50° field of view
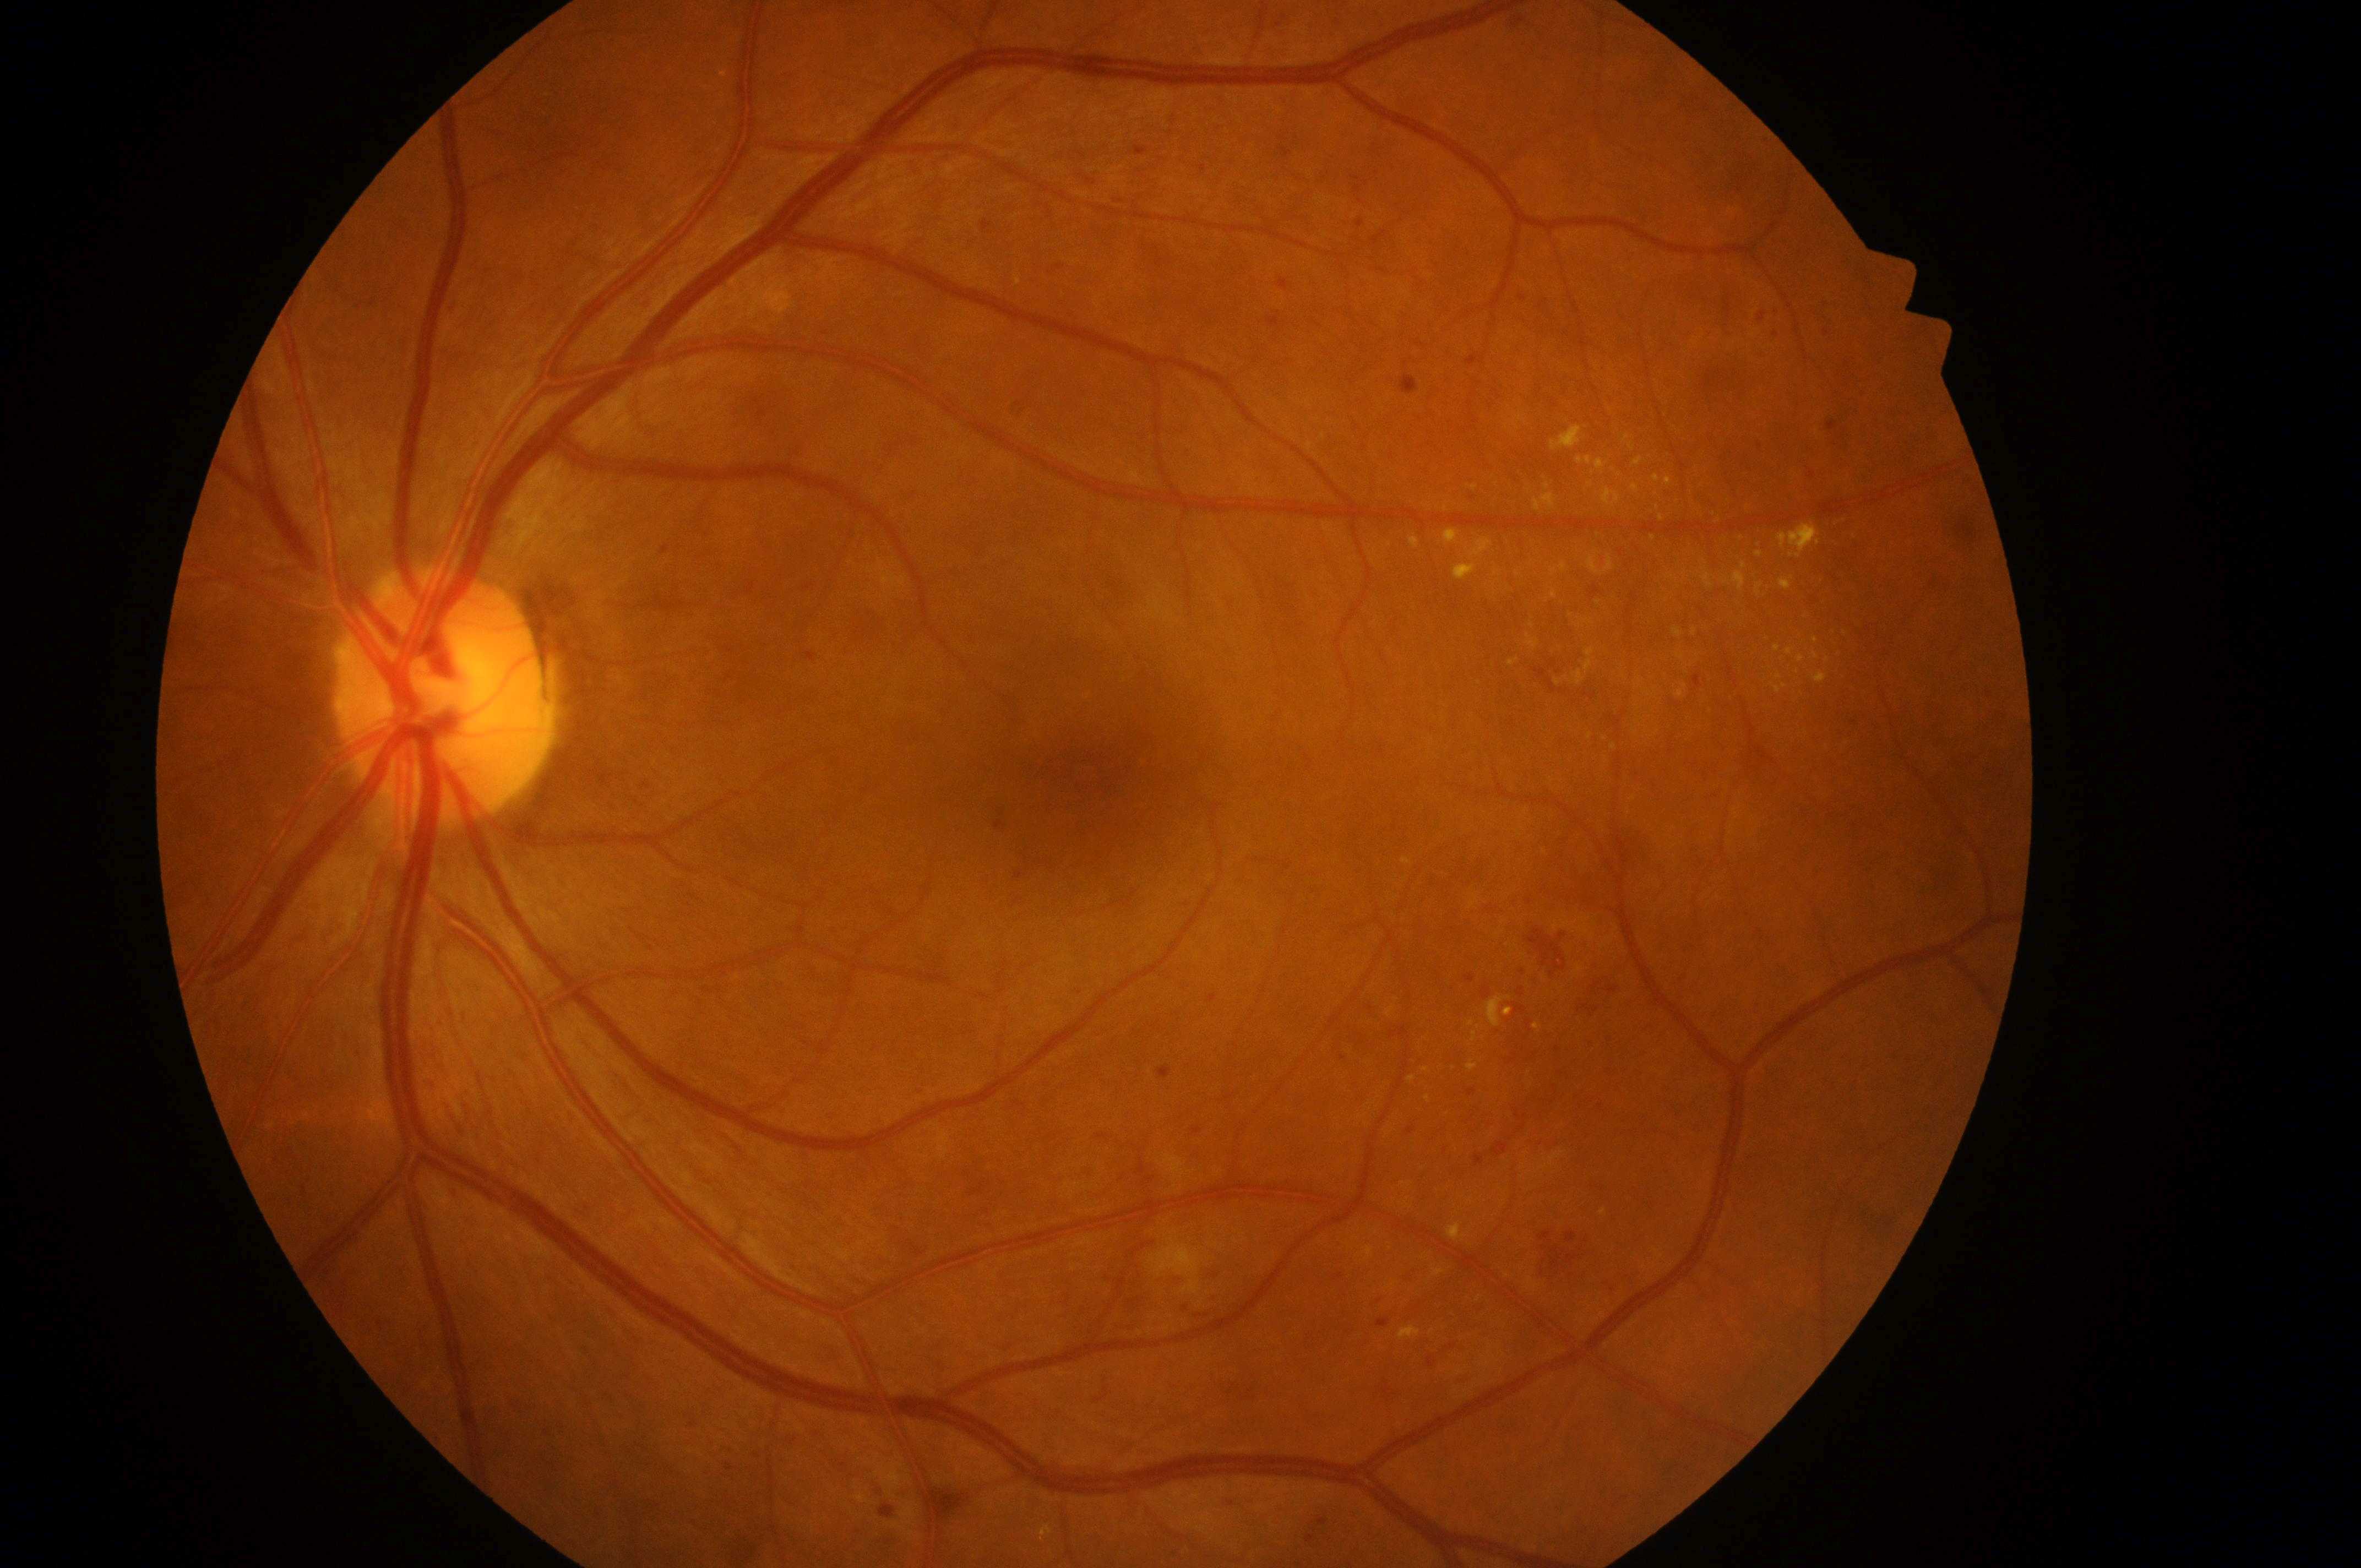 Annotations:
- DME: 1/2
- laterality: oculus sinister
- DR severity: 2/4
- foveal center: (x: 1095, y: 785)
- optic disc center: (x: 437, y: 703)